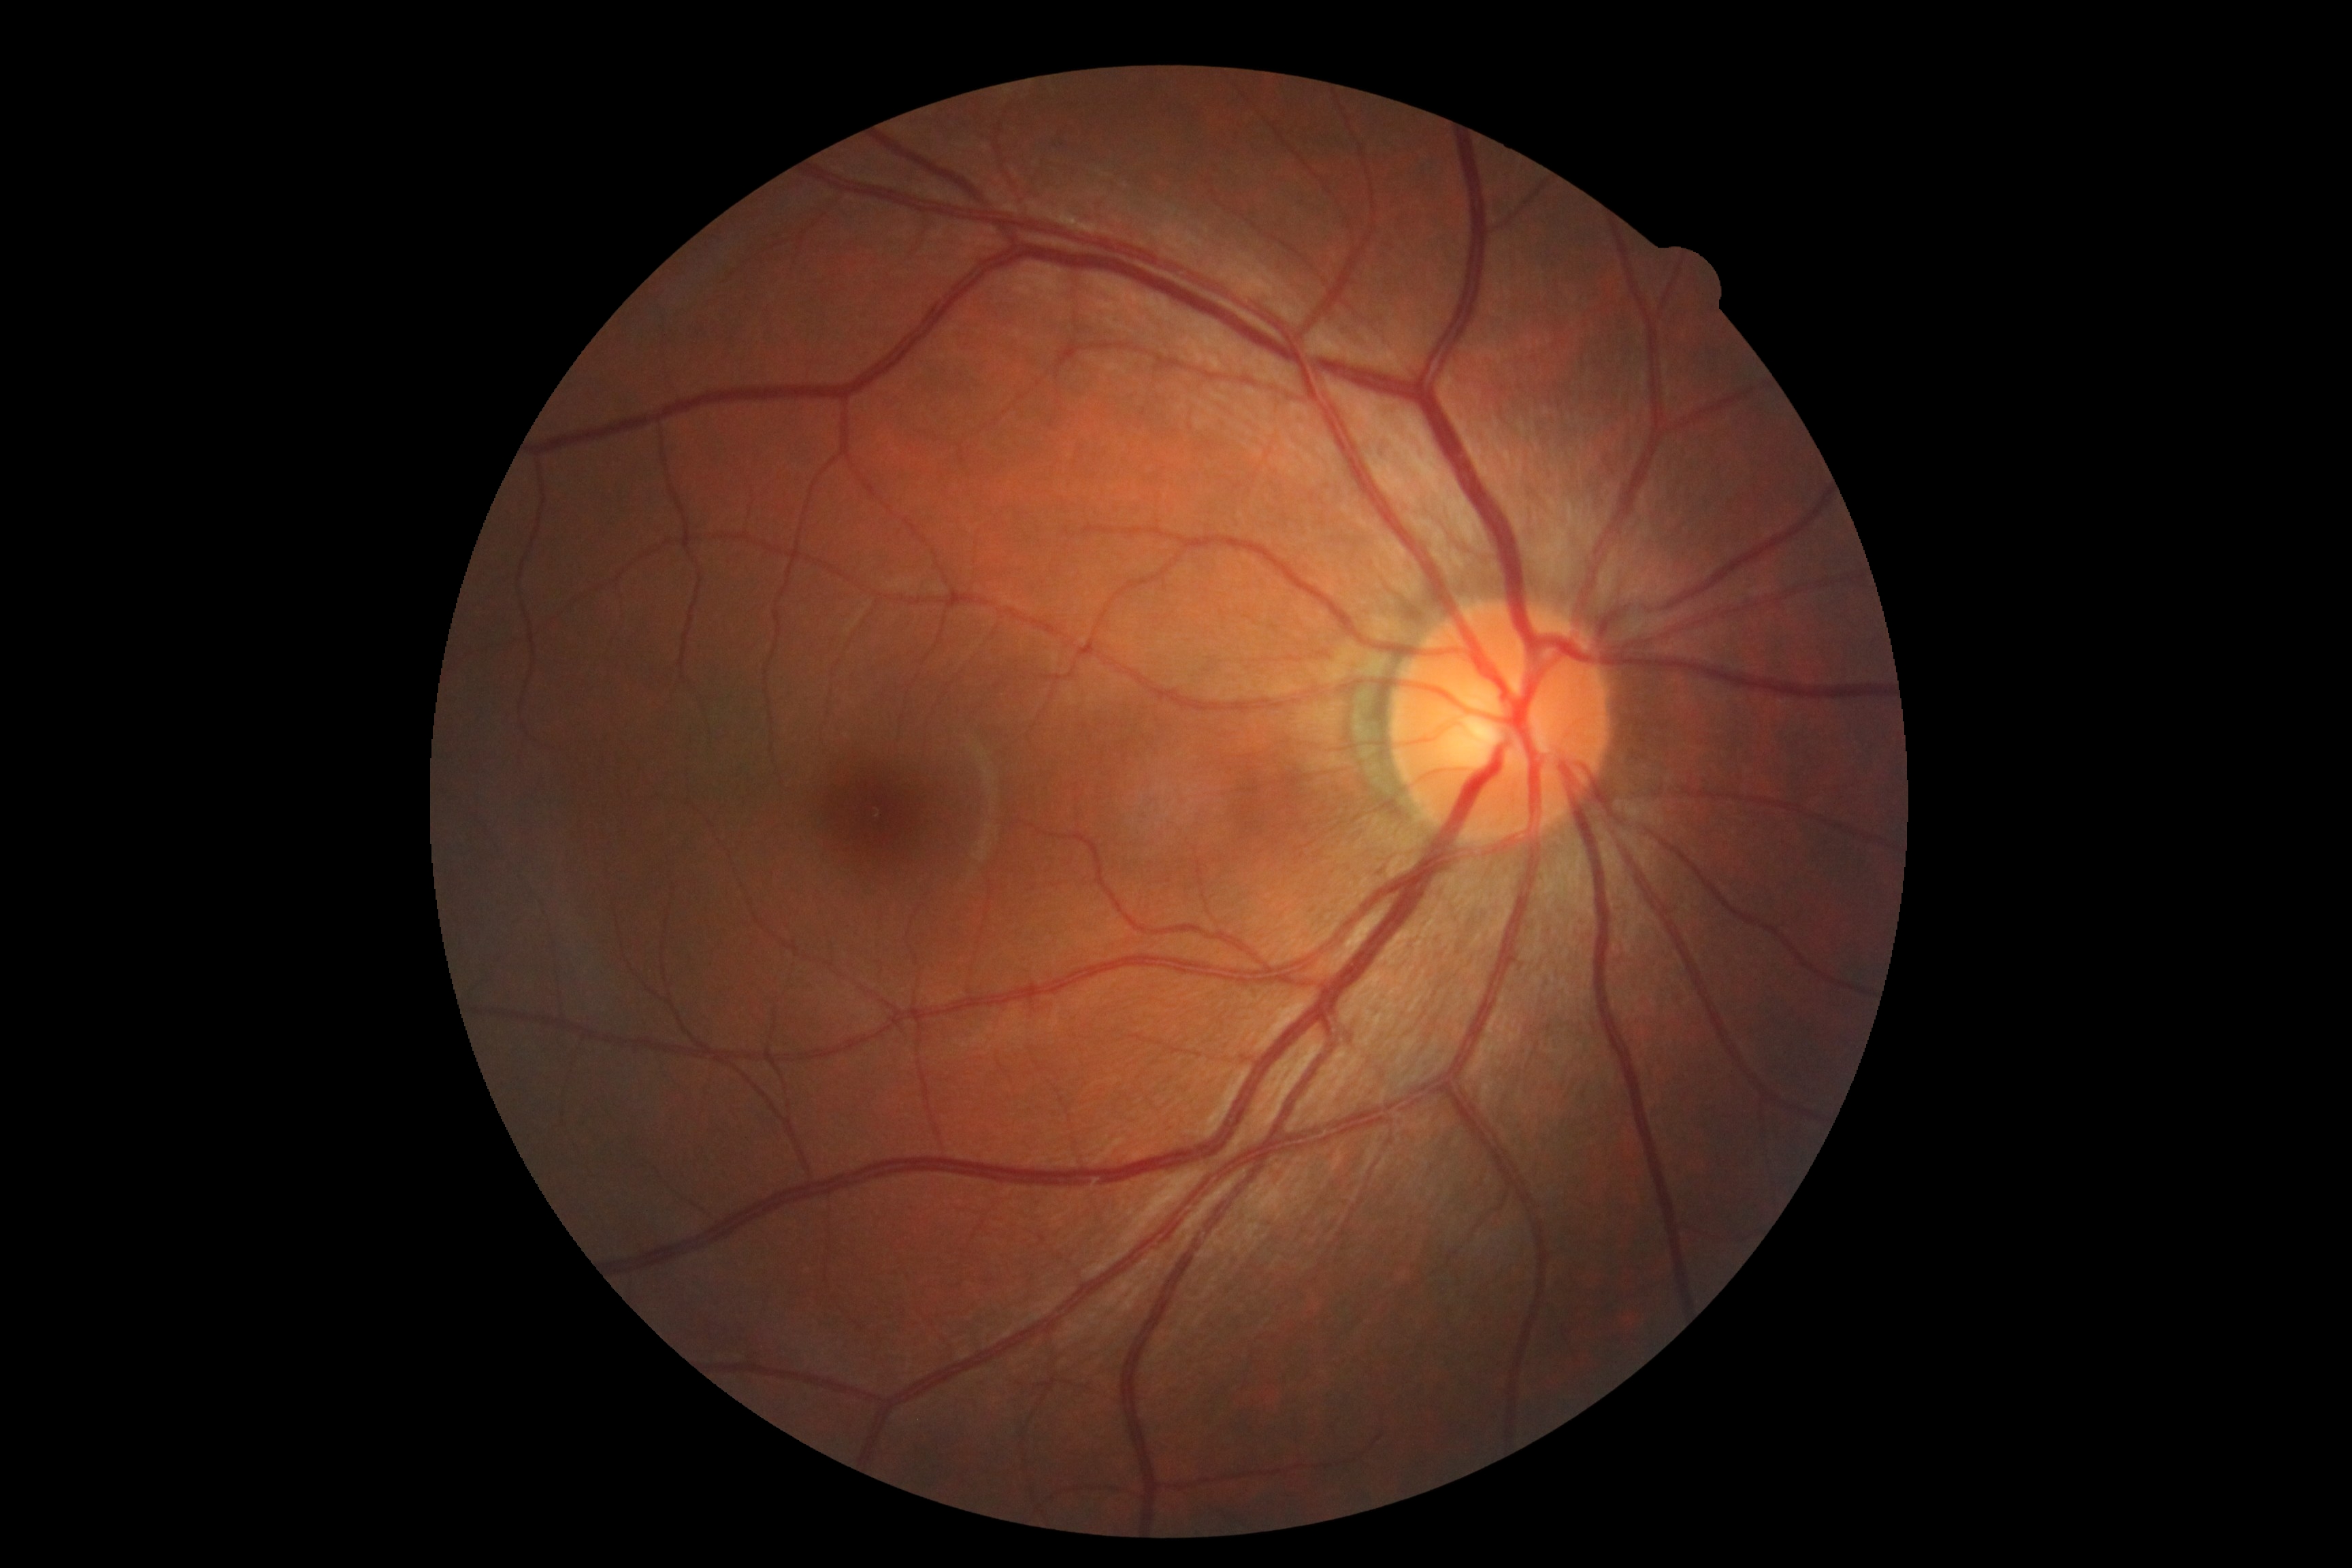 DR severity: 0/4 — no visible signs of diabetic retinopathy.